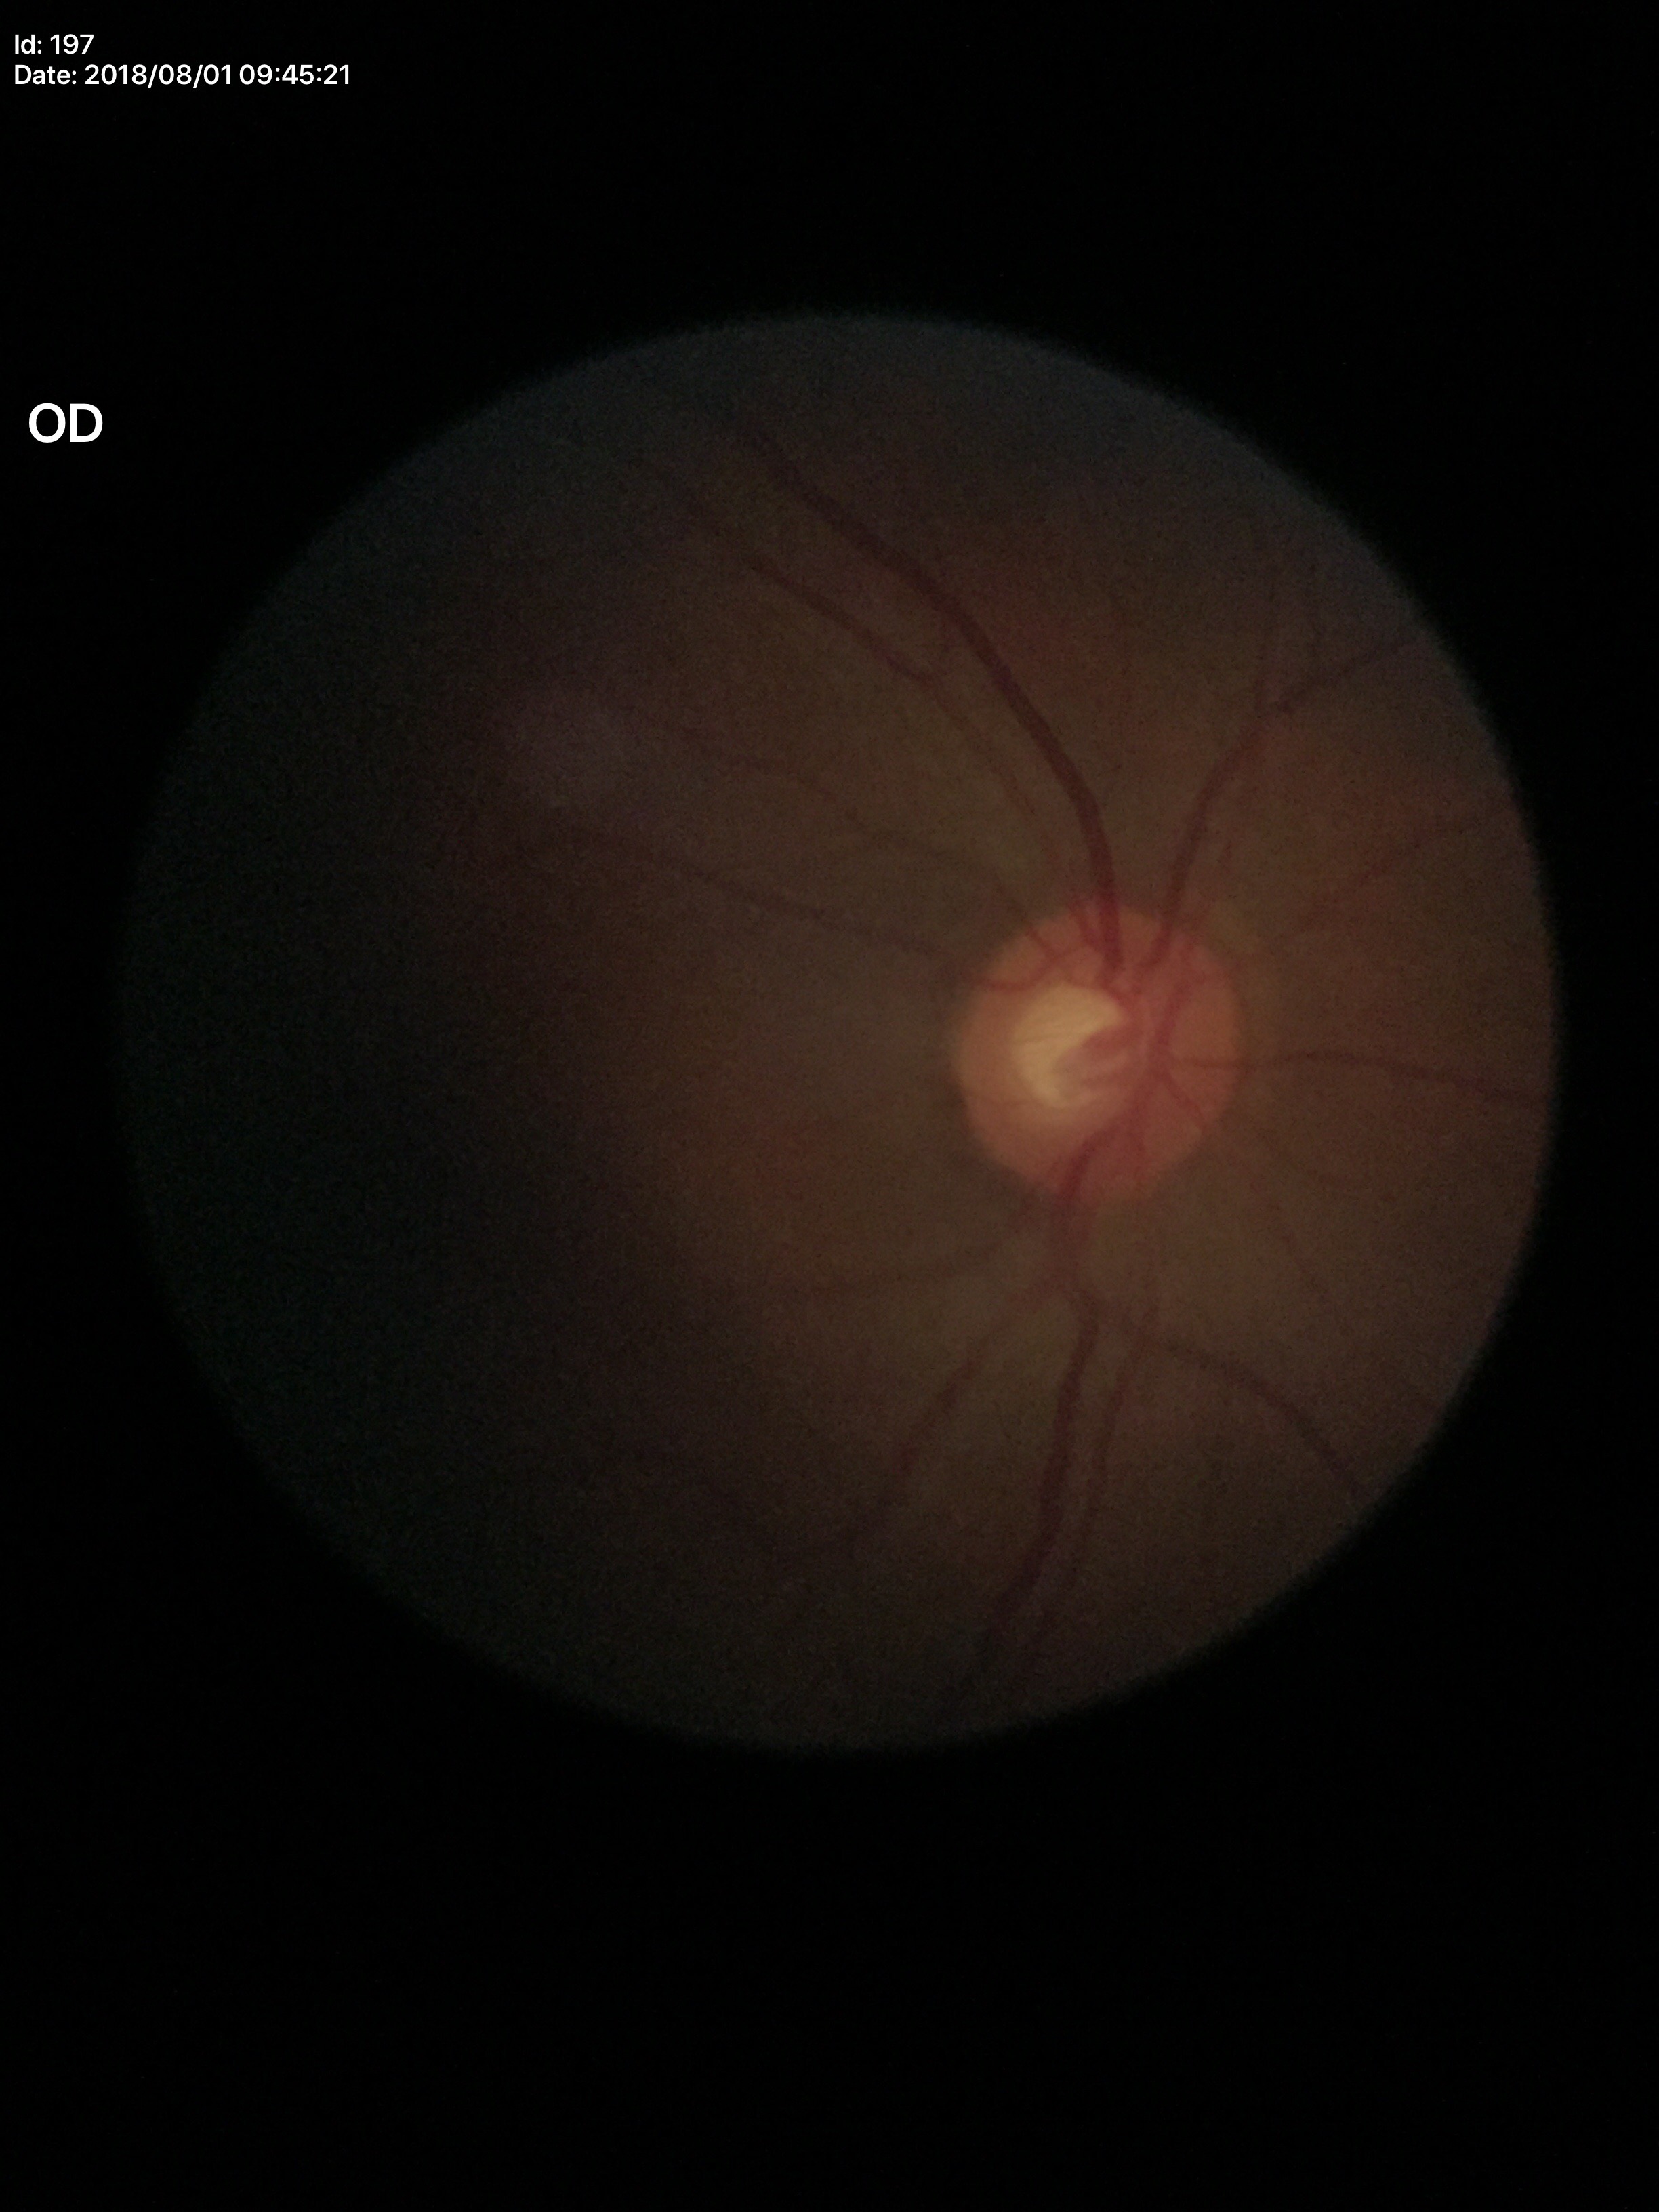 No glaucomatous optic neuropathy (all 5 graders called normal). Vertical cup-disc ratio (VCDR): 0.52.